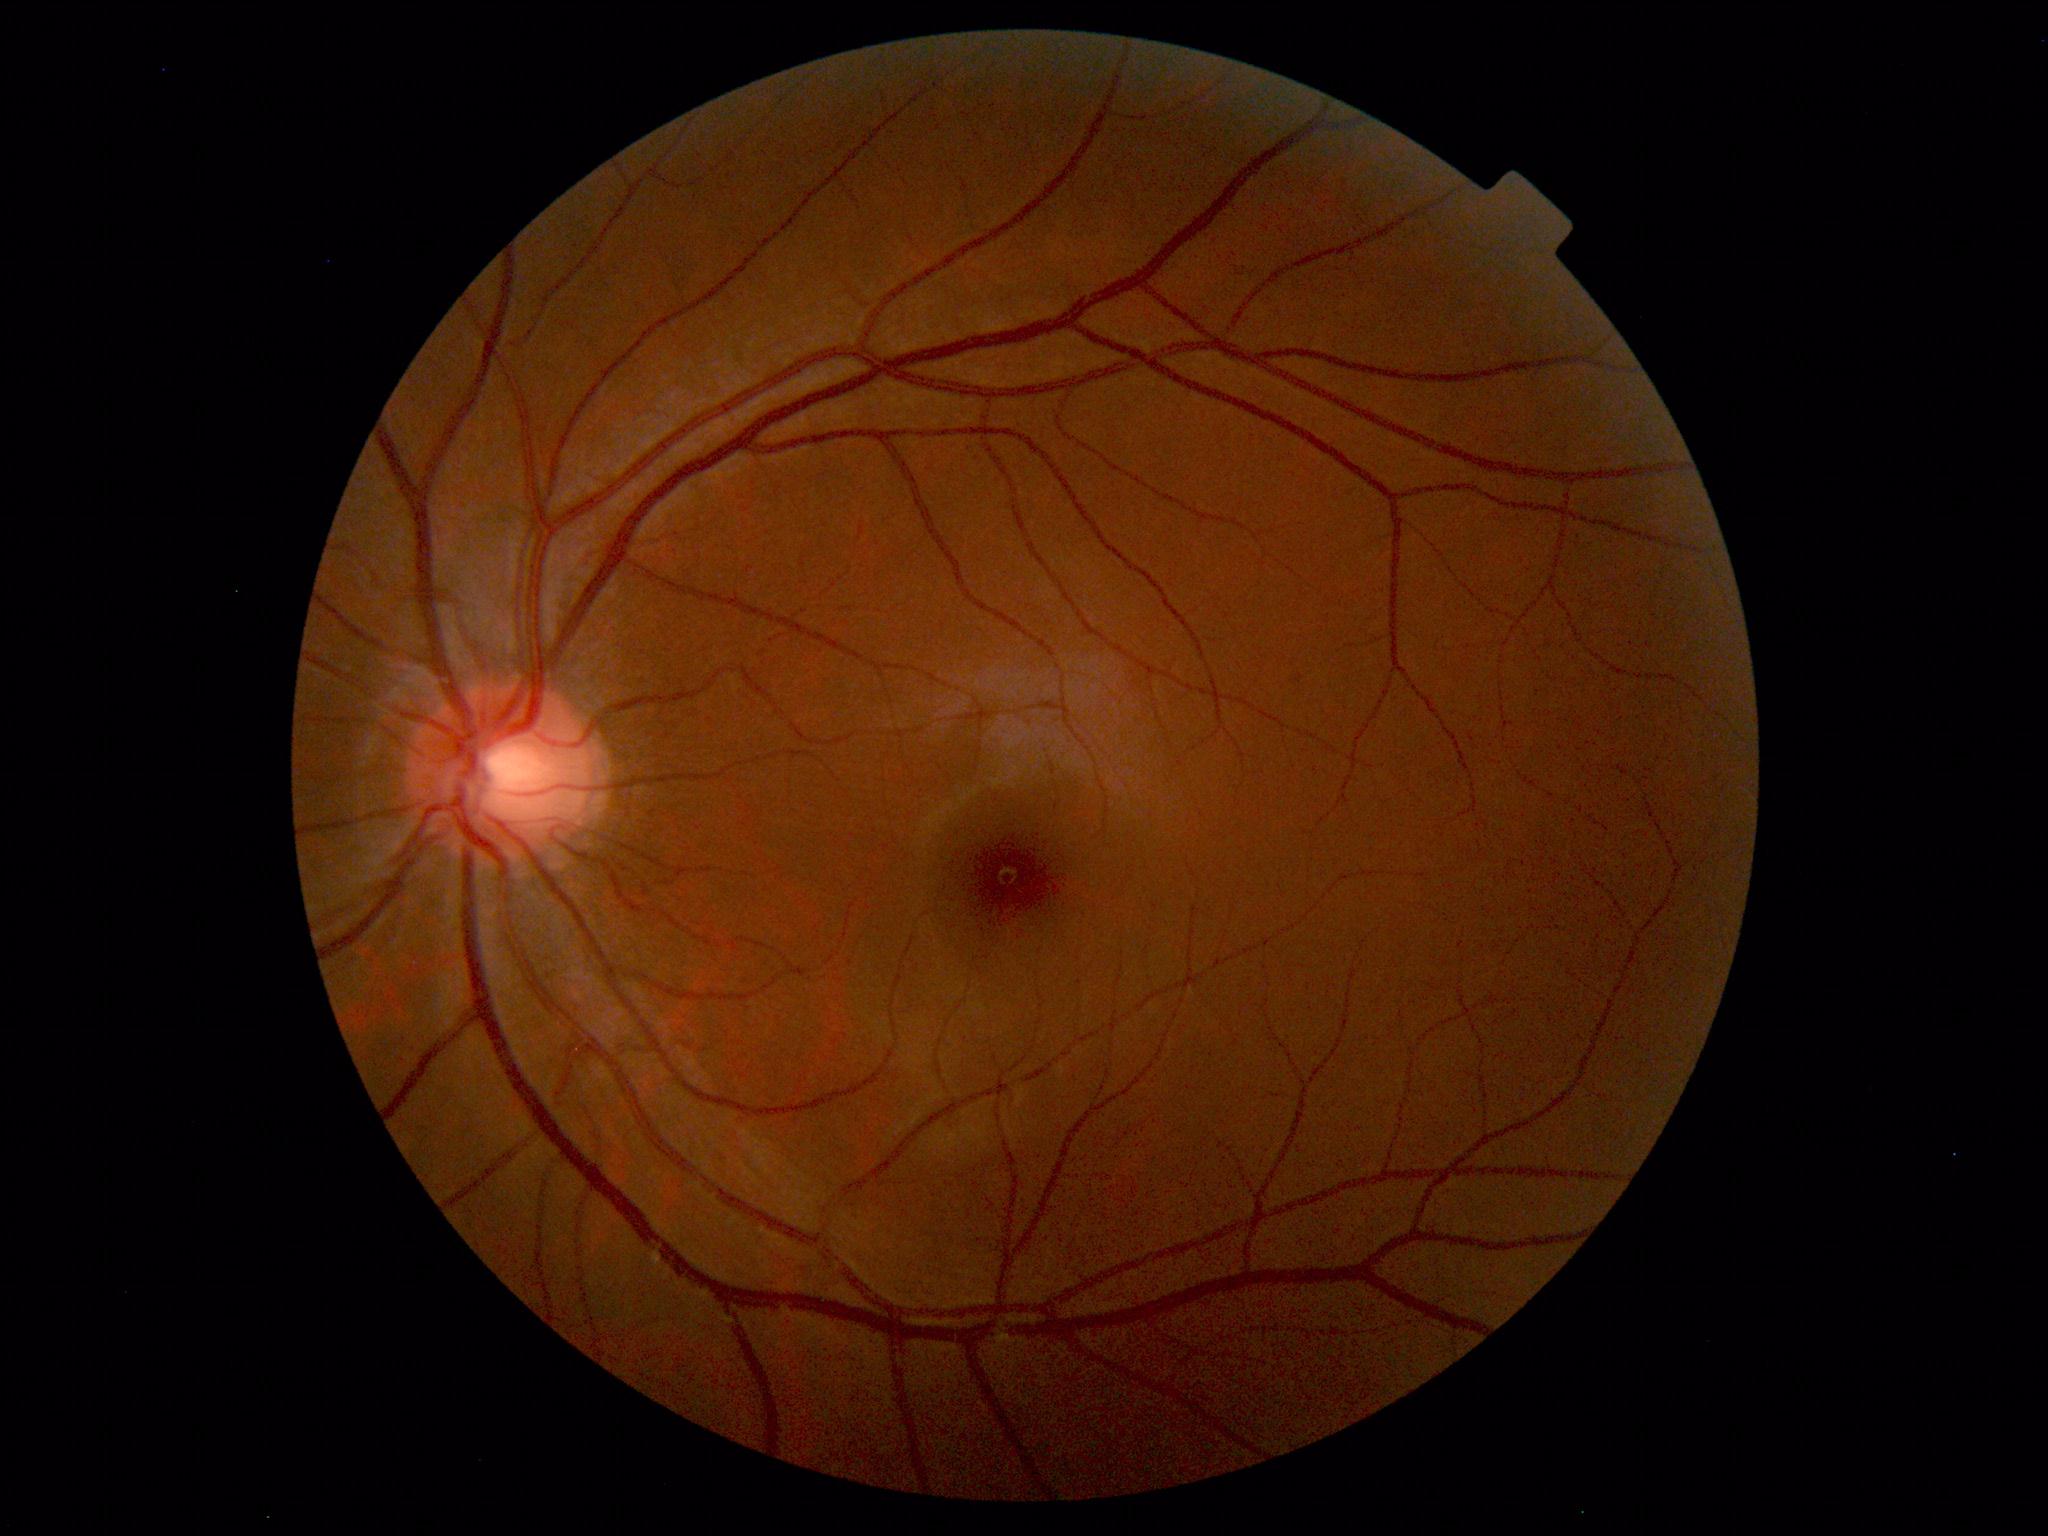 Diagnosis: normal.